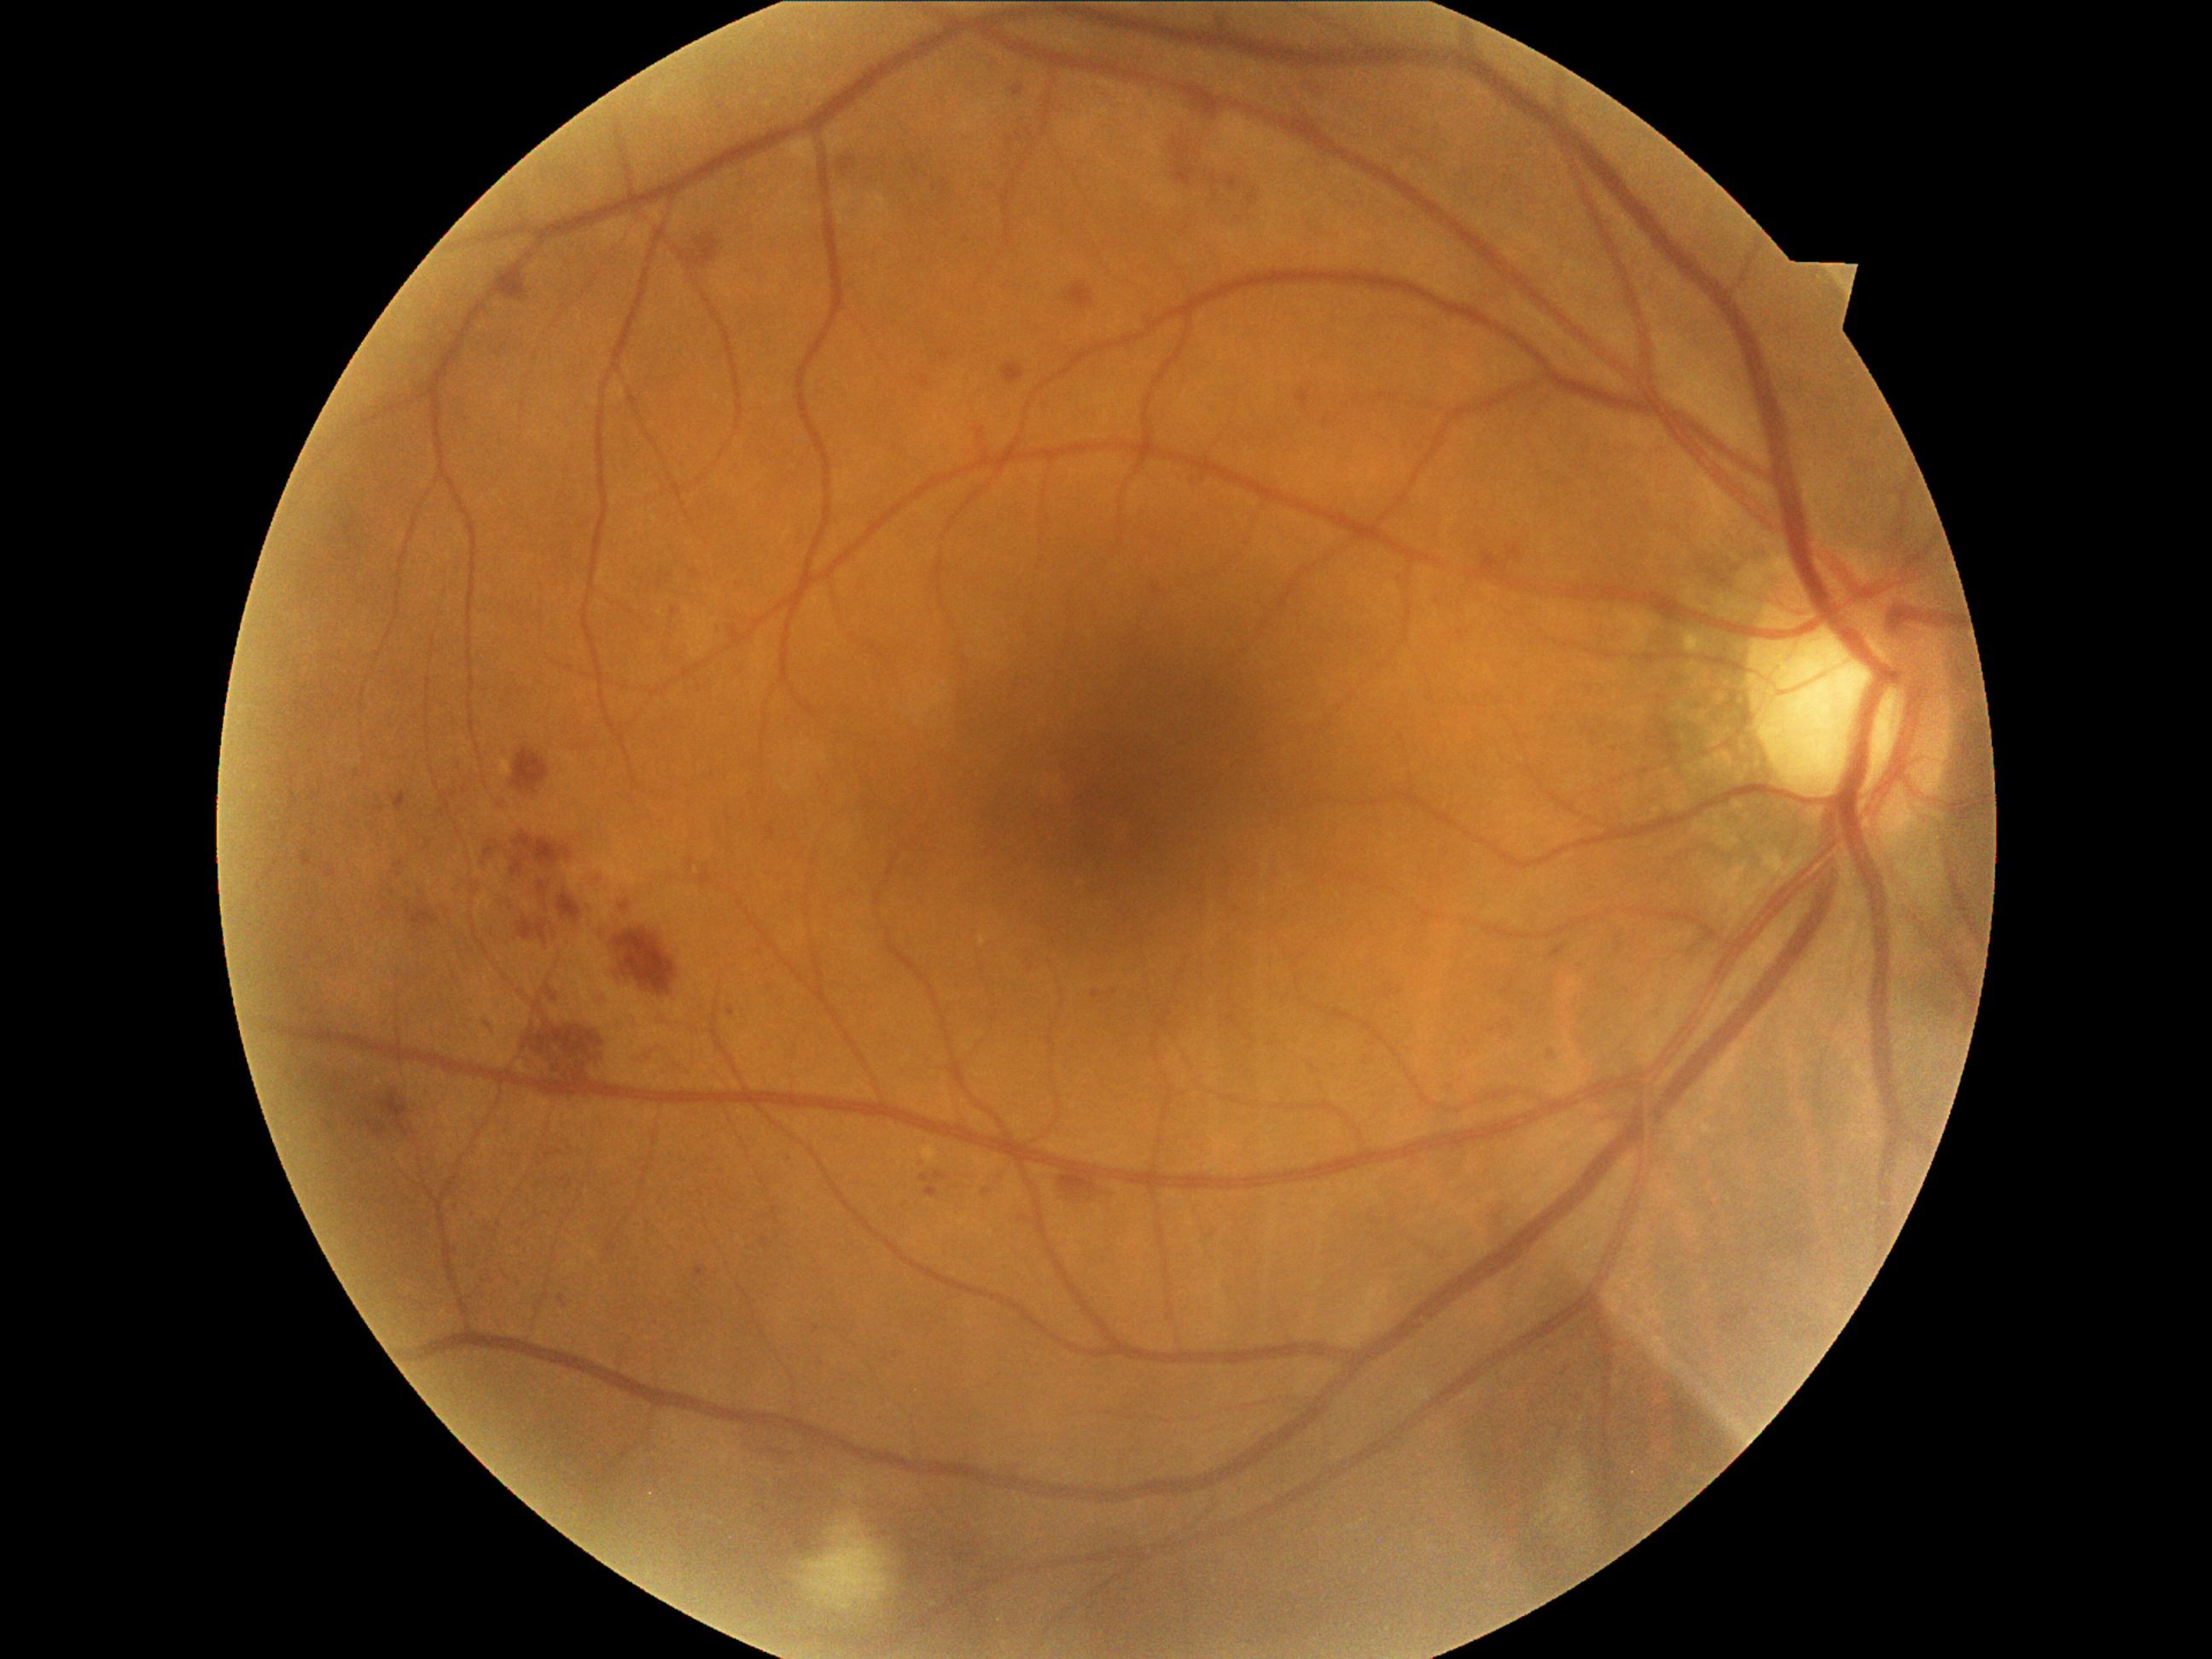

dr_grade: grade 2 (moderate NPDR)